35° field of view before cropping. Optic nerve head photograph
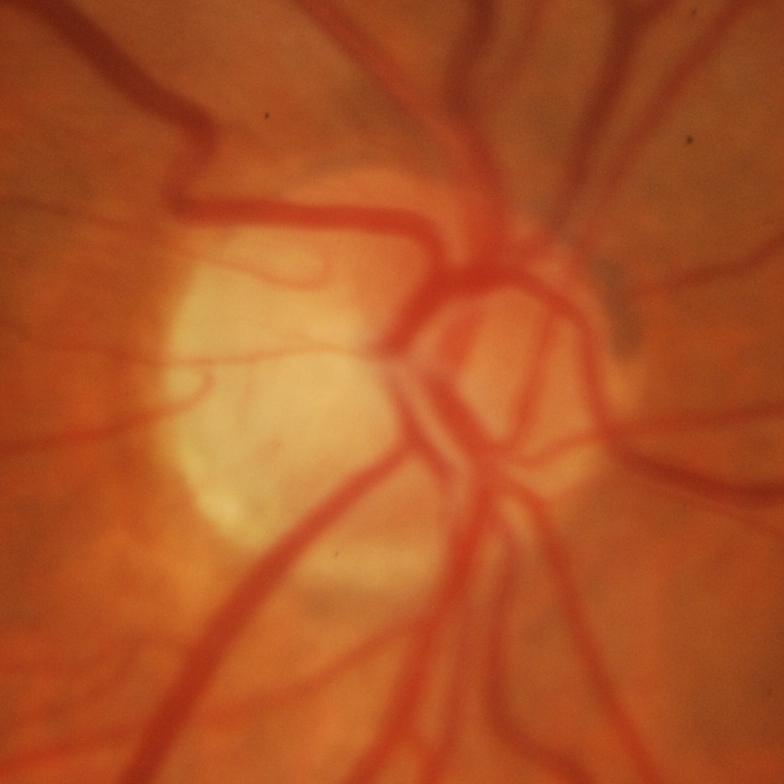 Glaucoma is present.
Glaucoma.